Wide-field fundus image from infant ROP screening · Clarity RetCam 3, 130° FOV · 640 by 480 pixels.
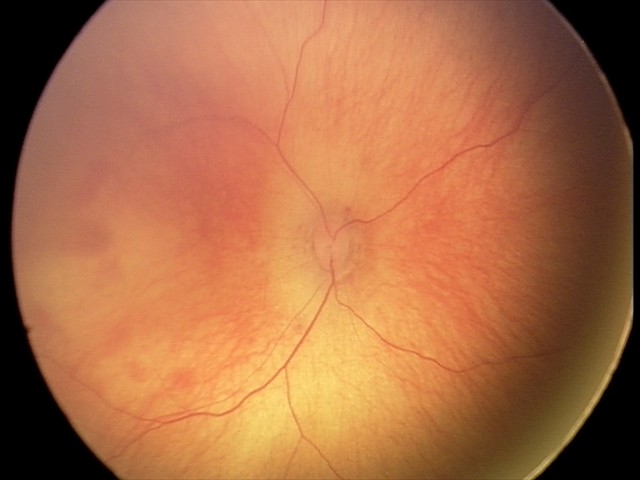
Series diagnosed as retinal hemorrhages.